FOV: 45 degrees; 1960x1897: 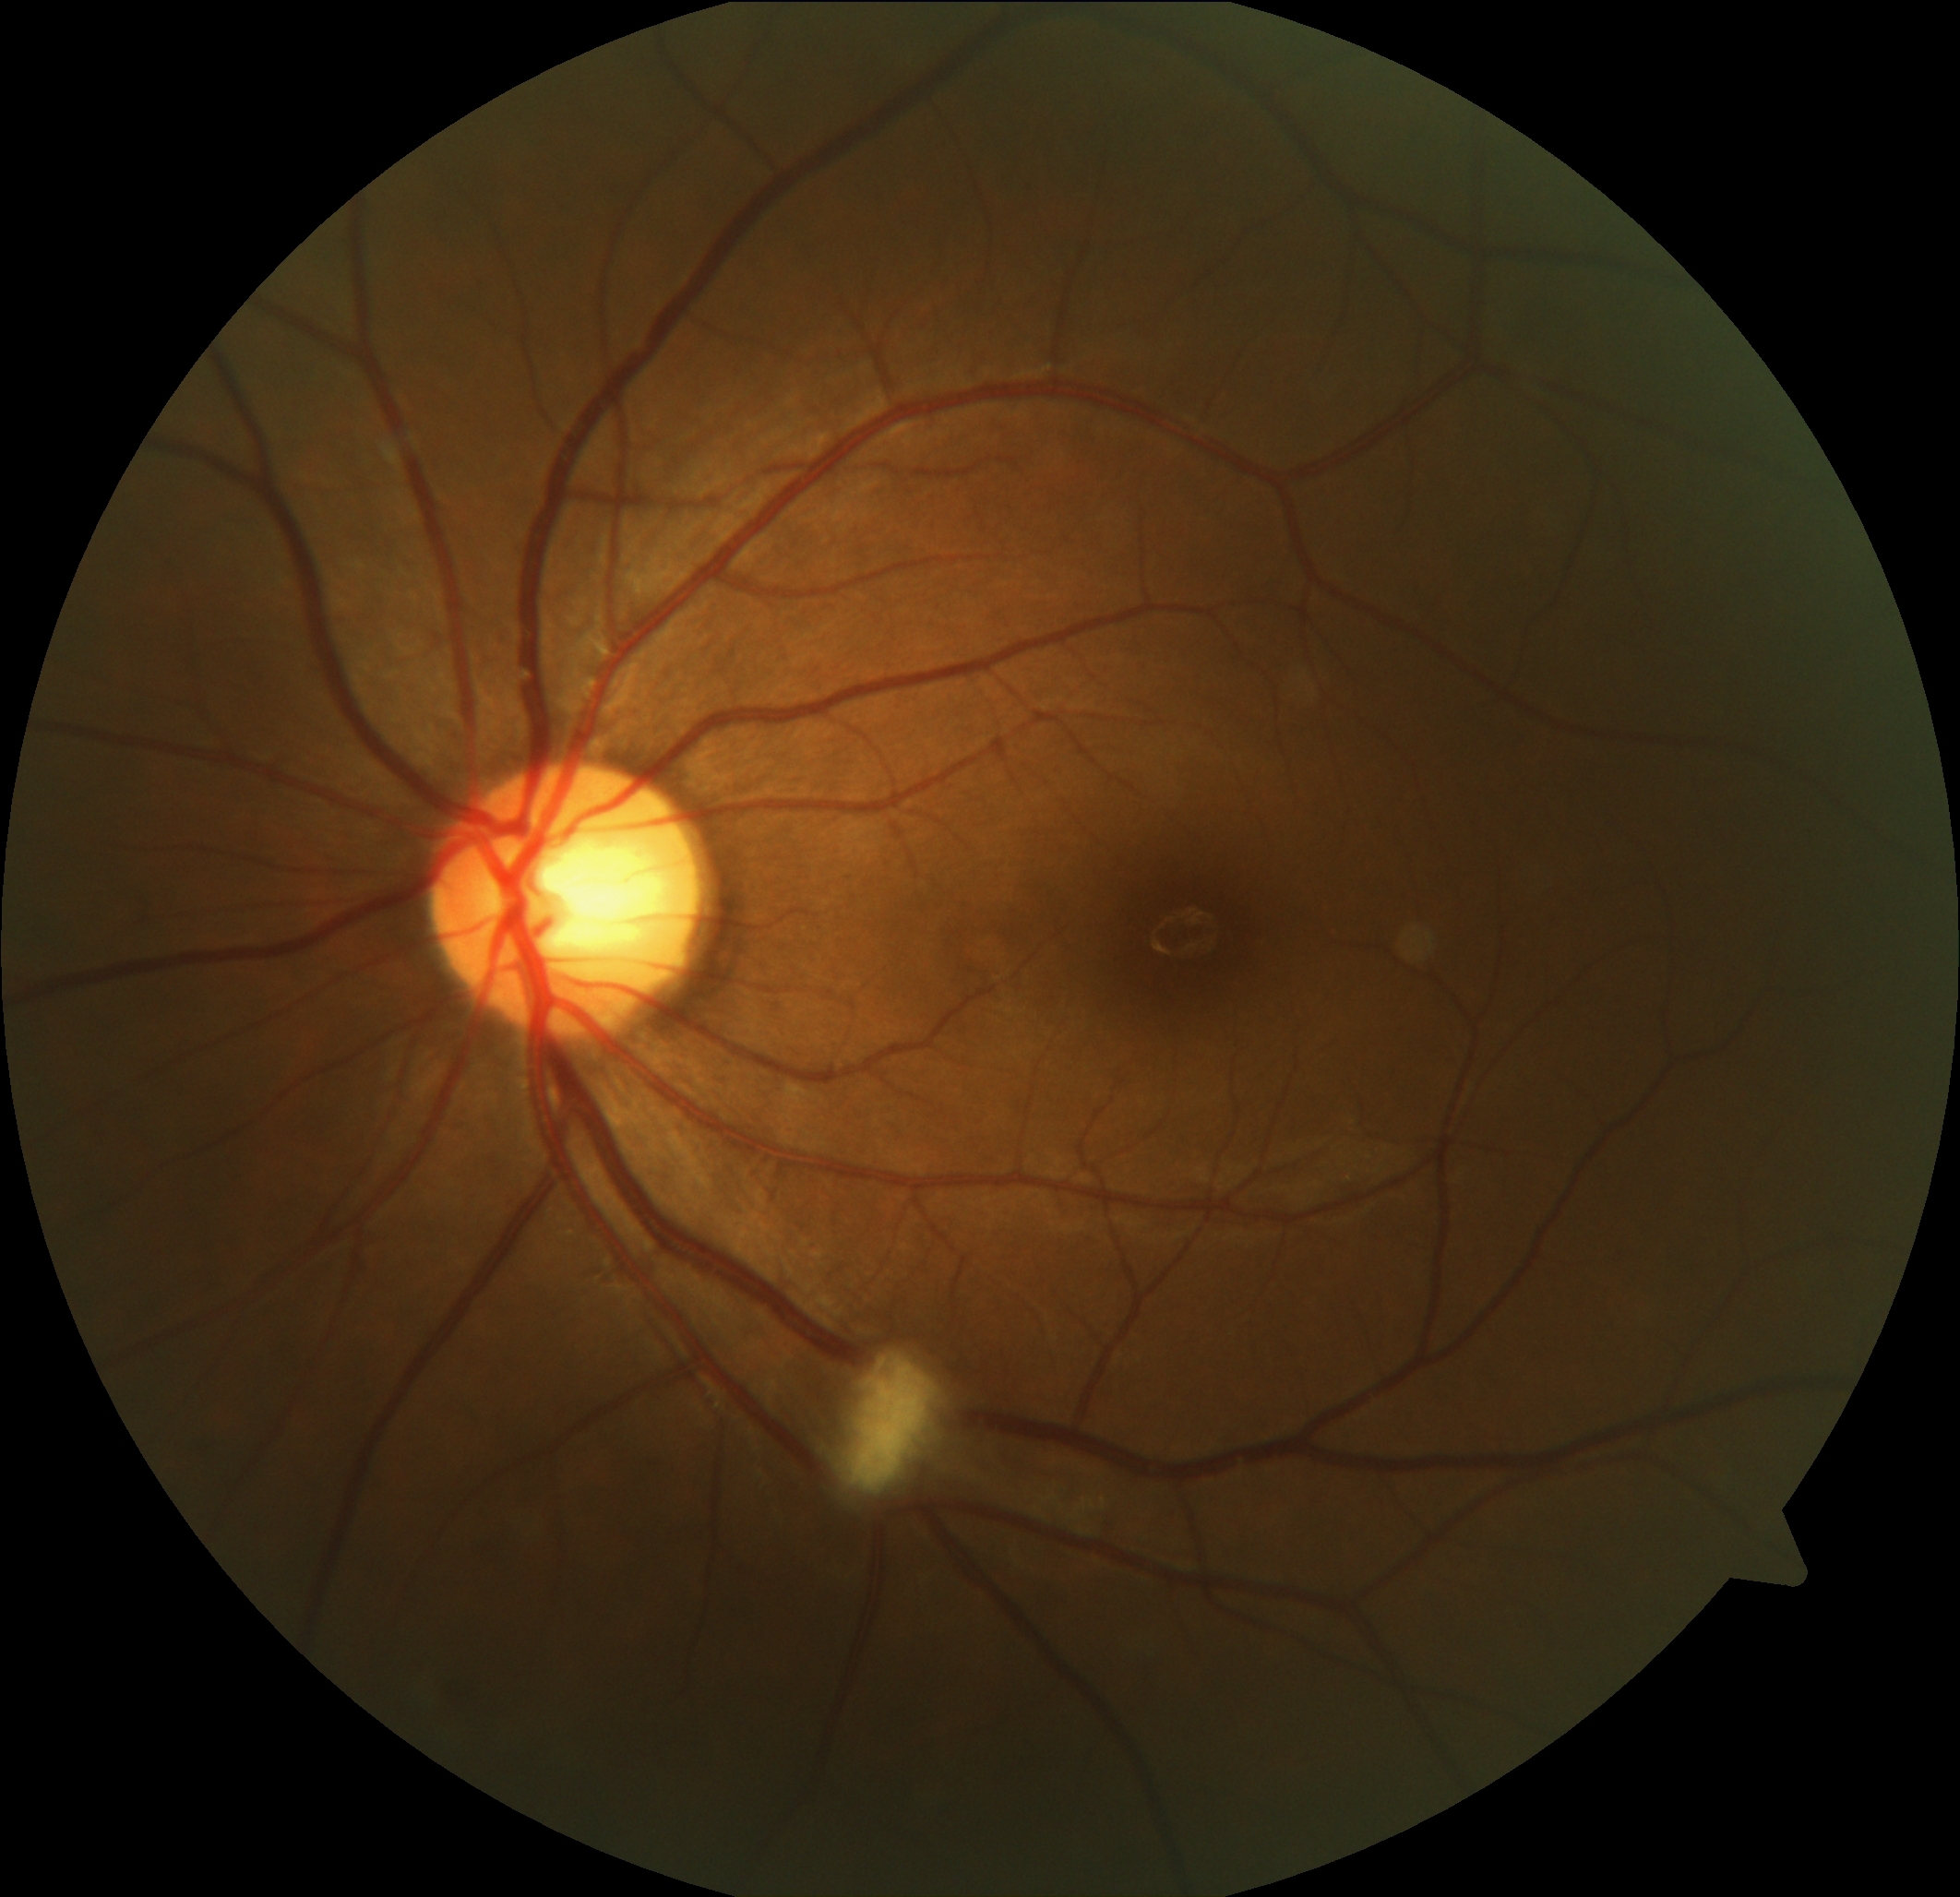
{"dr_category": "non-proliferative diabetic retinopathy", "dr_grade": "2 — more than just microaneurysms but less than severe NPDR"}